45° FOV; 2352 by 1568 pixels — 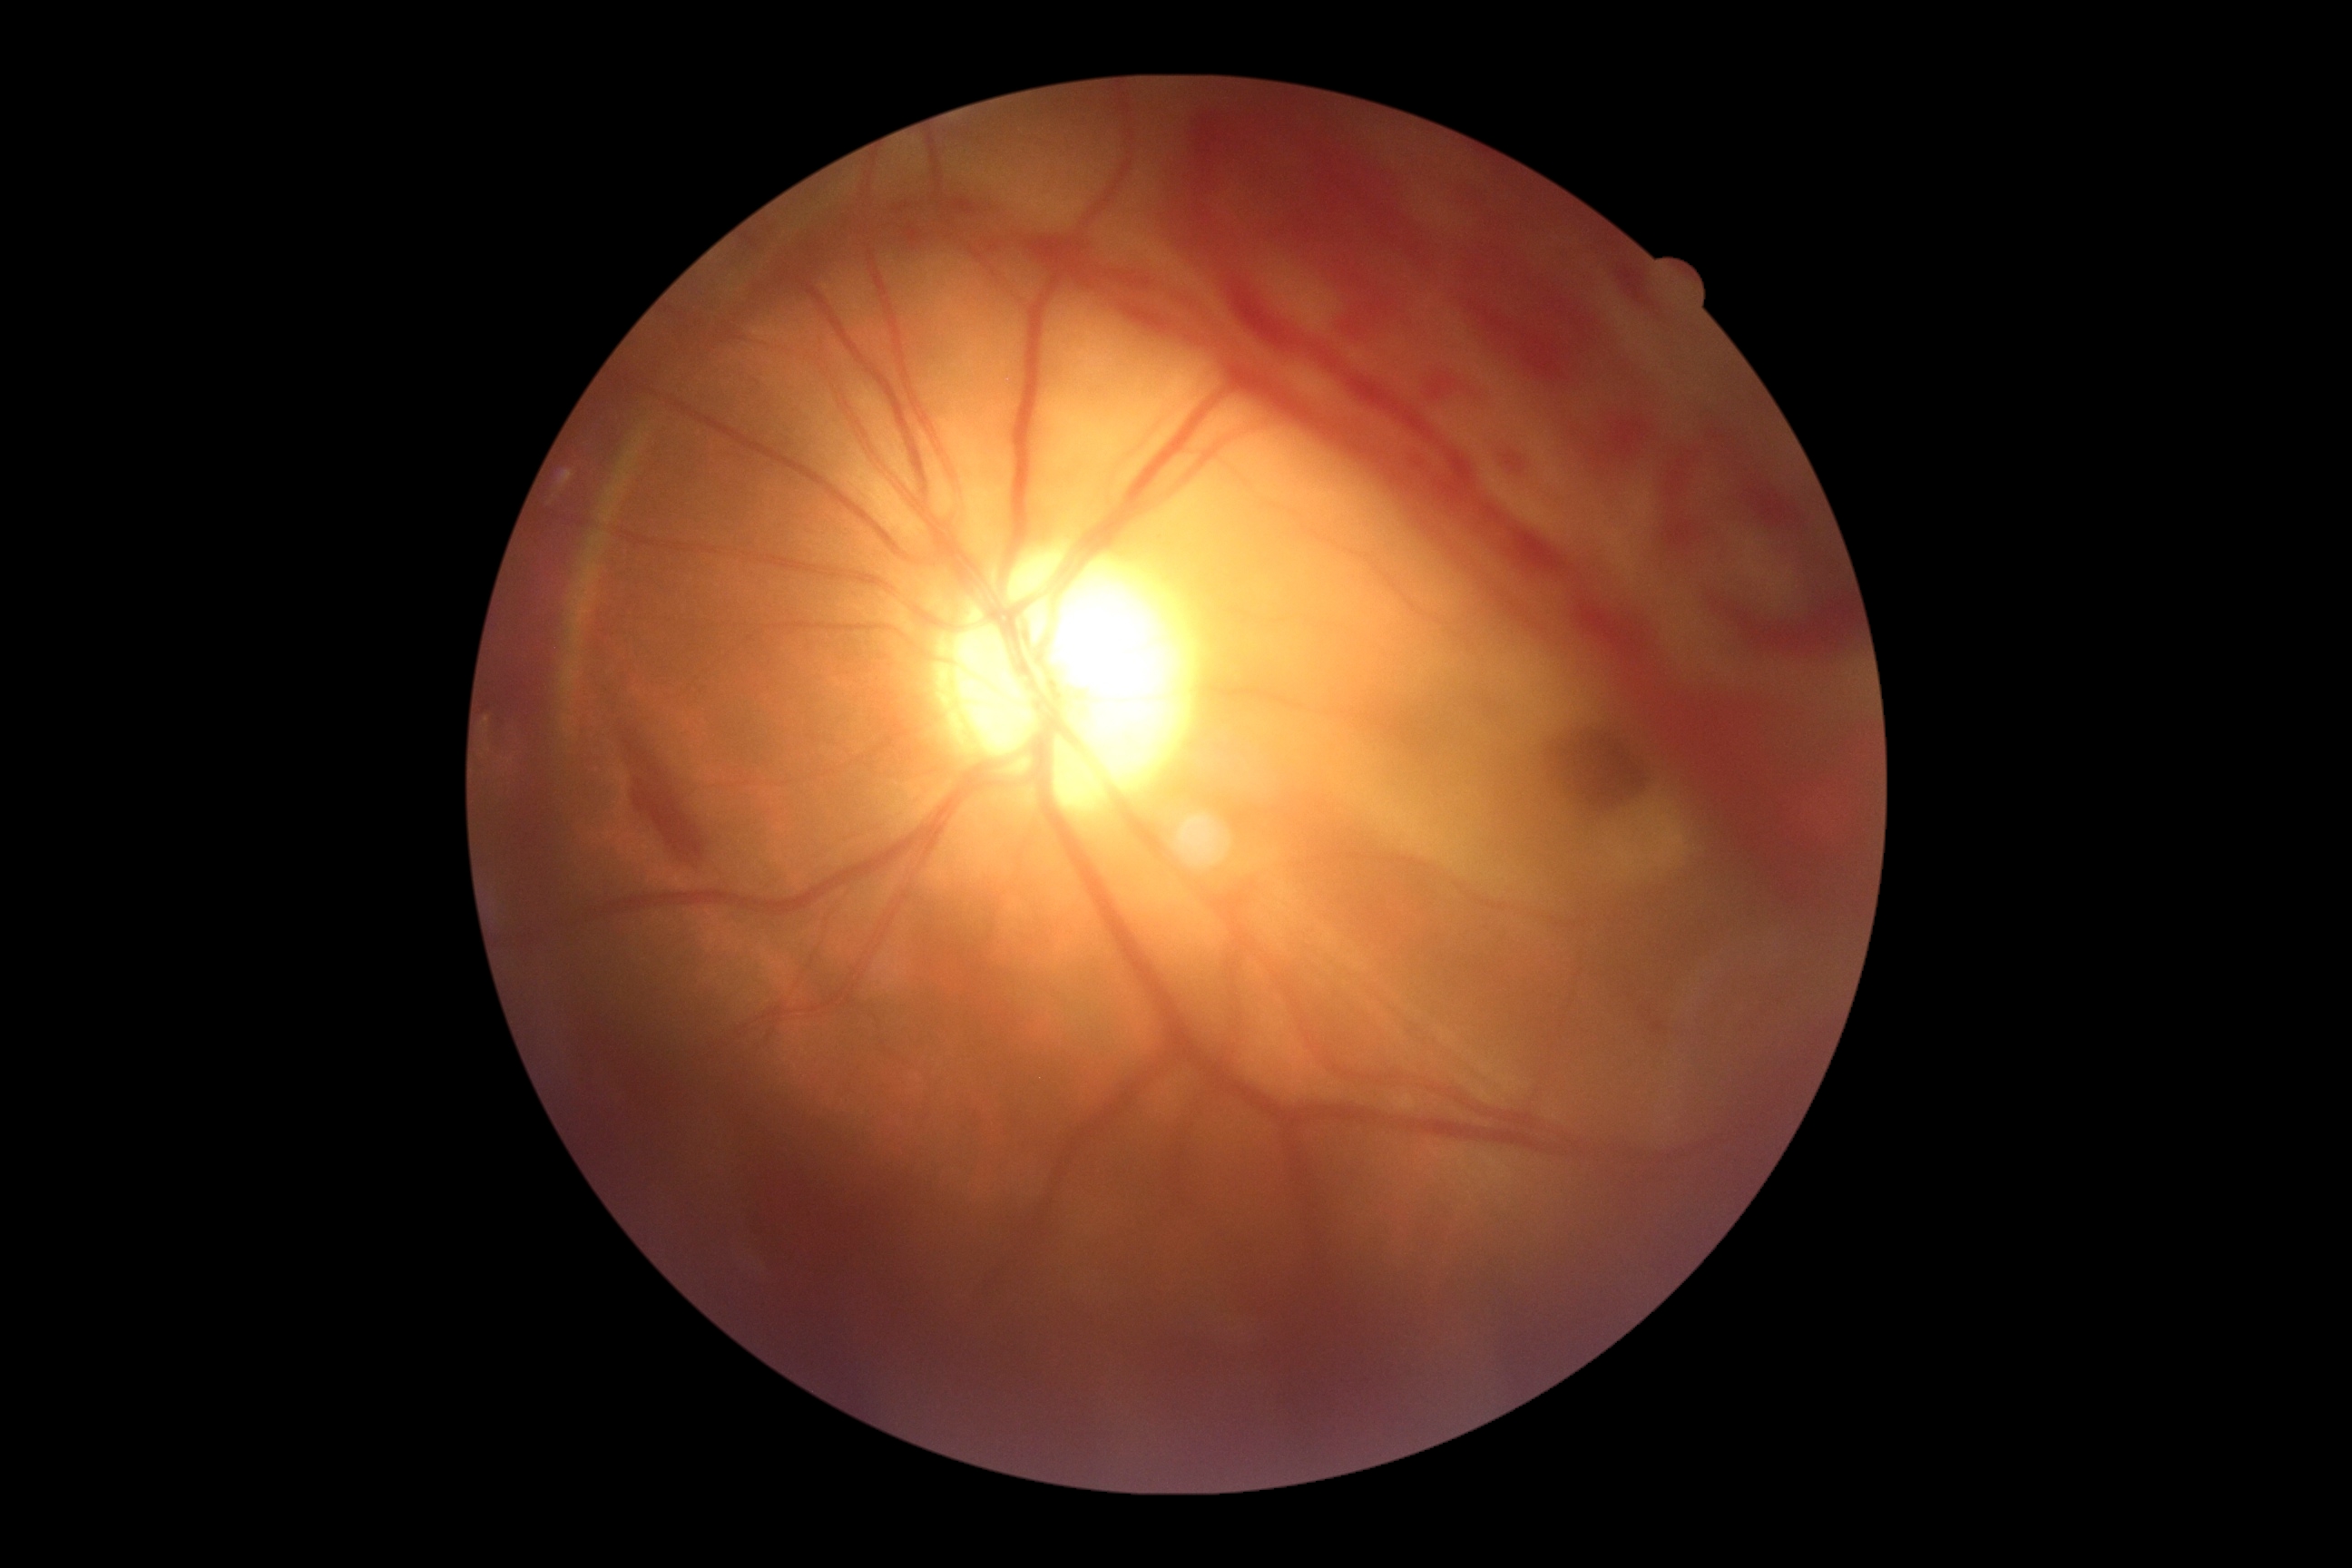

Disease class: proliferative diabetic retinopathy. DR severity: grade 4 (PDR).